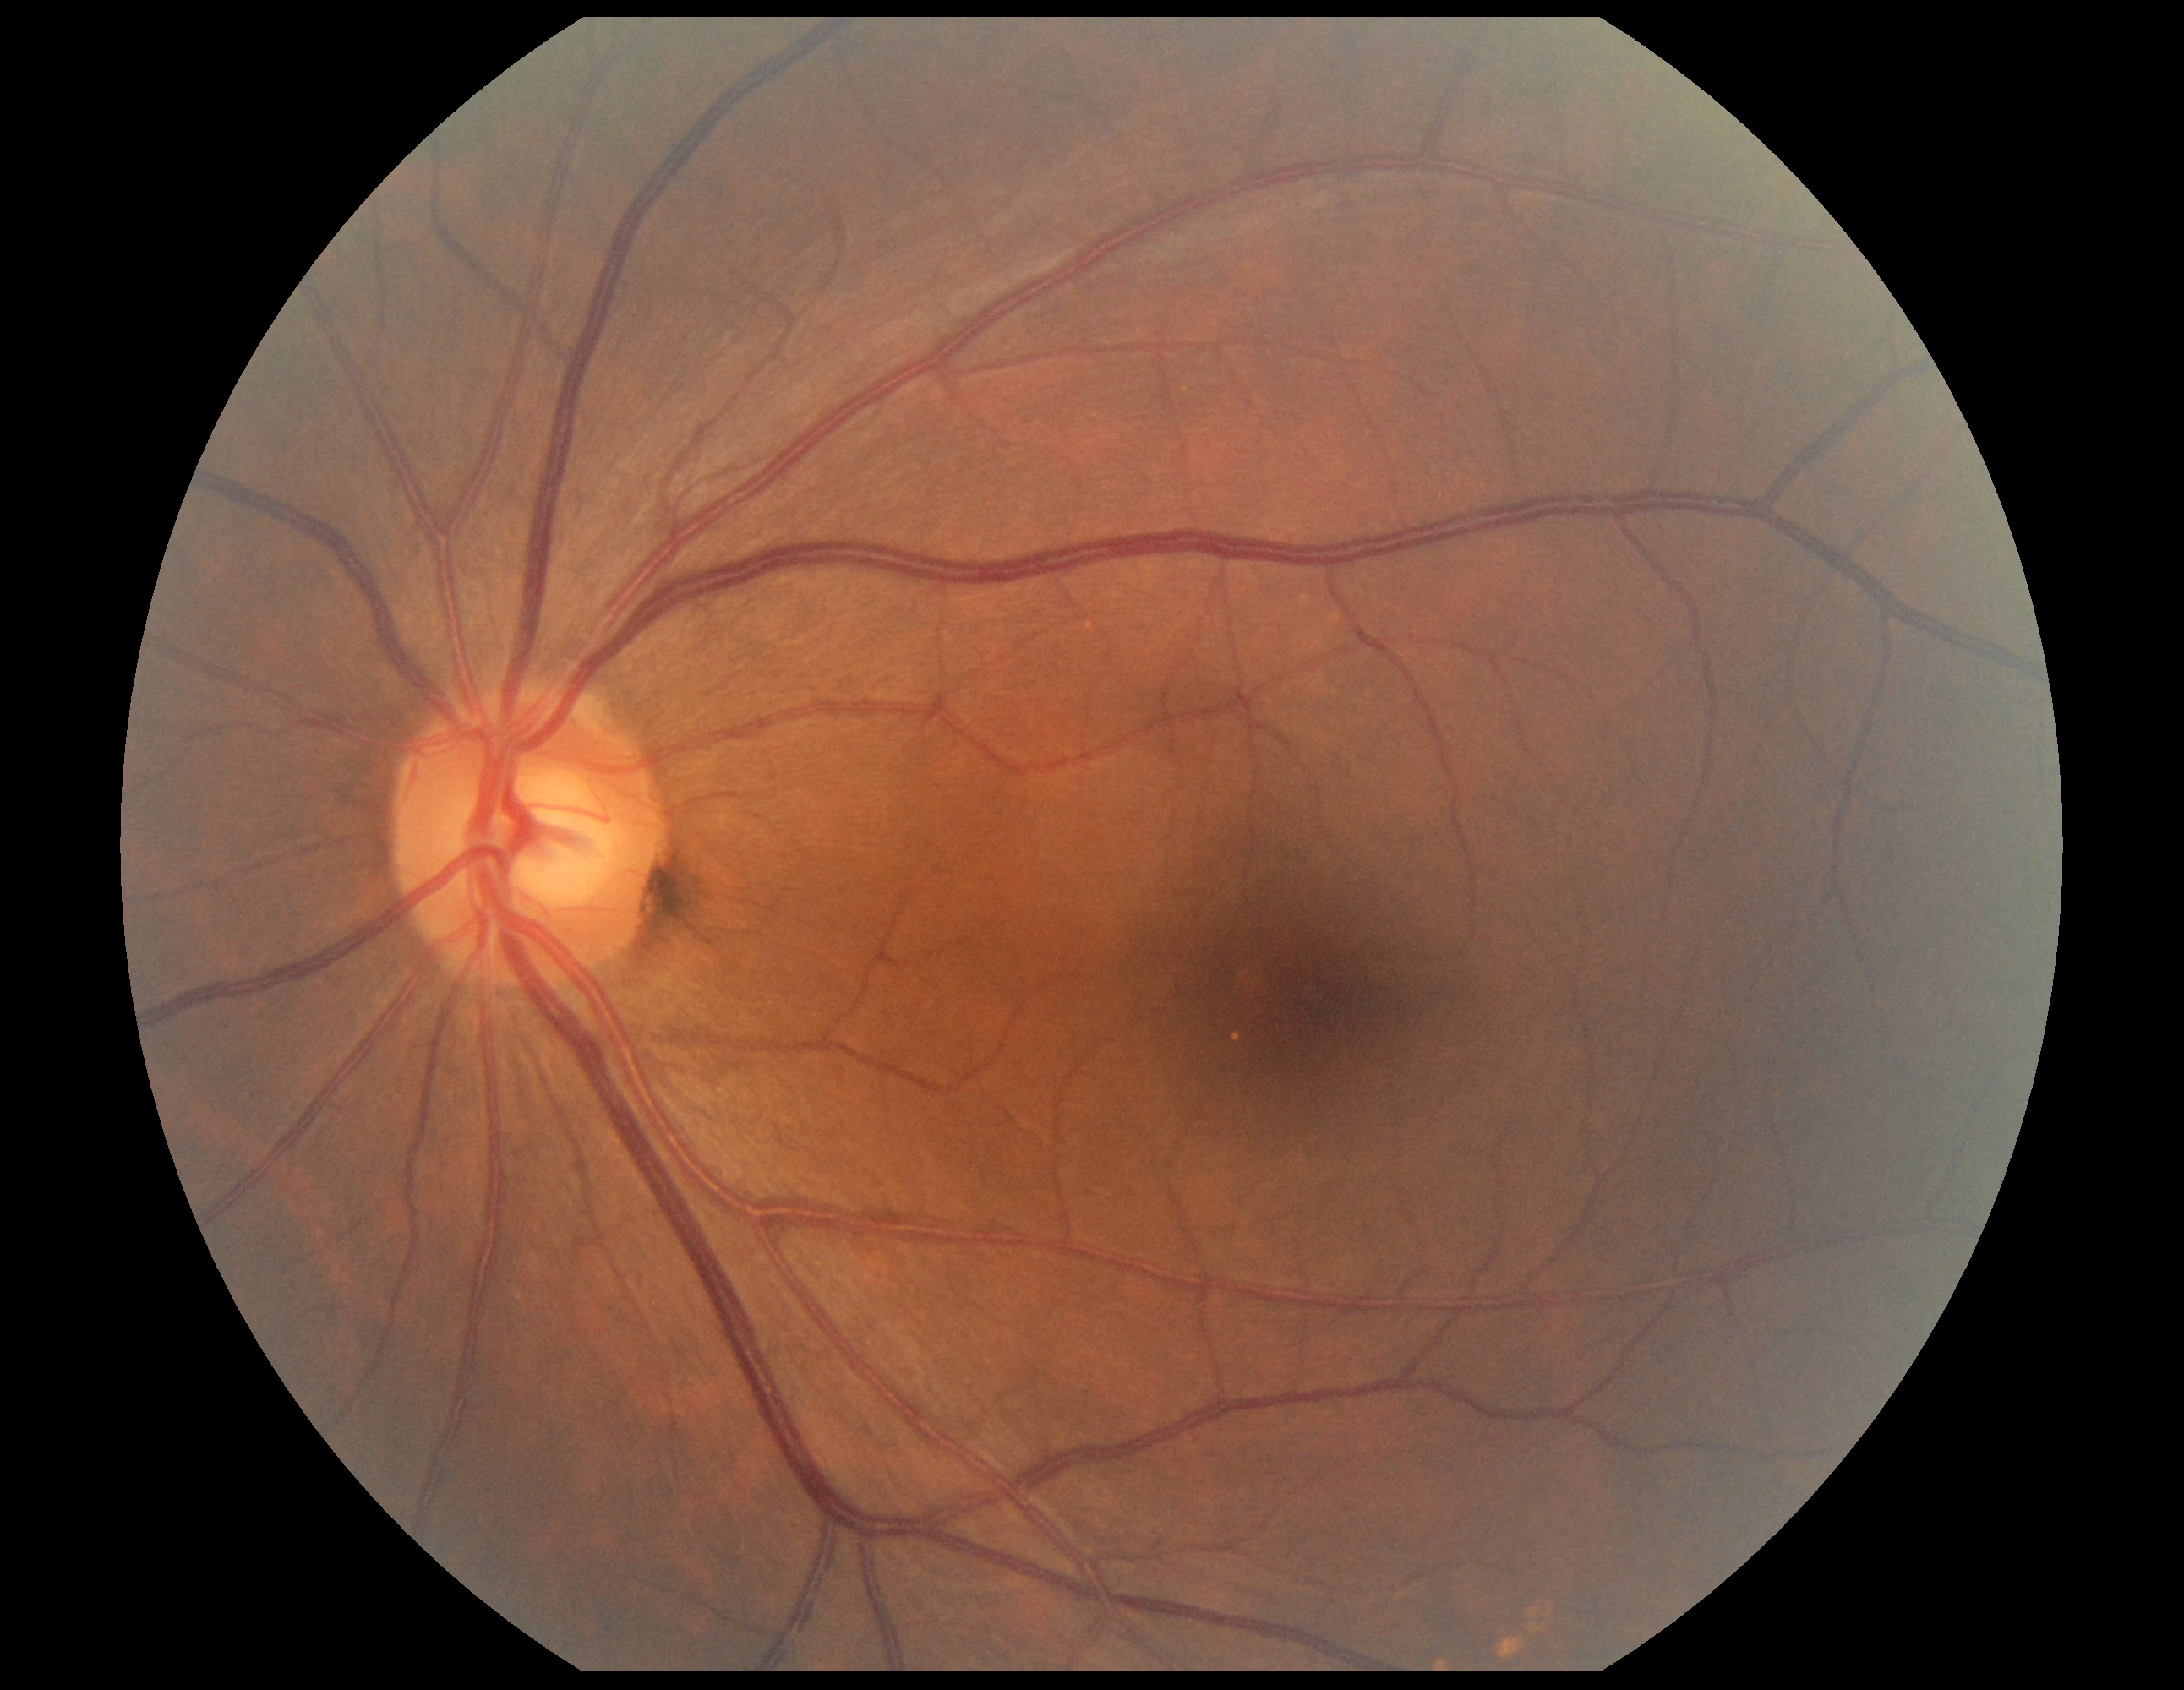
Retinopathy grade is 0 (no apparent retinopathy).